Camera: NIDEK AFC-230, 848 by 848 pixels, 45 degree fundus photograph, nonmydriatic.
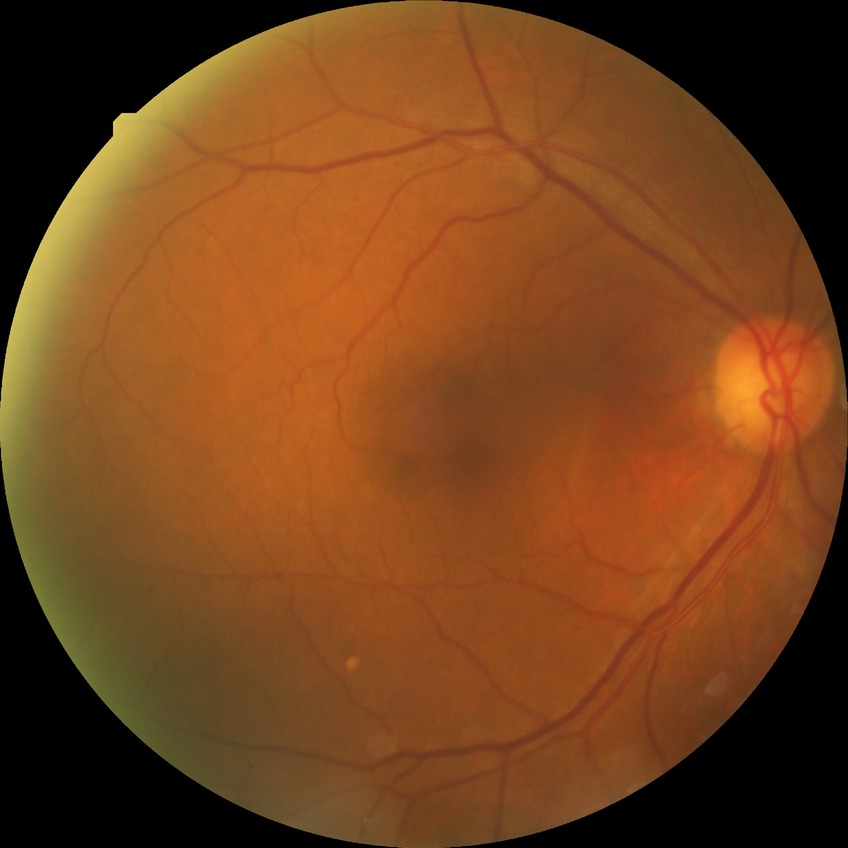
modified Davis classification: no diabetic retinopathy